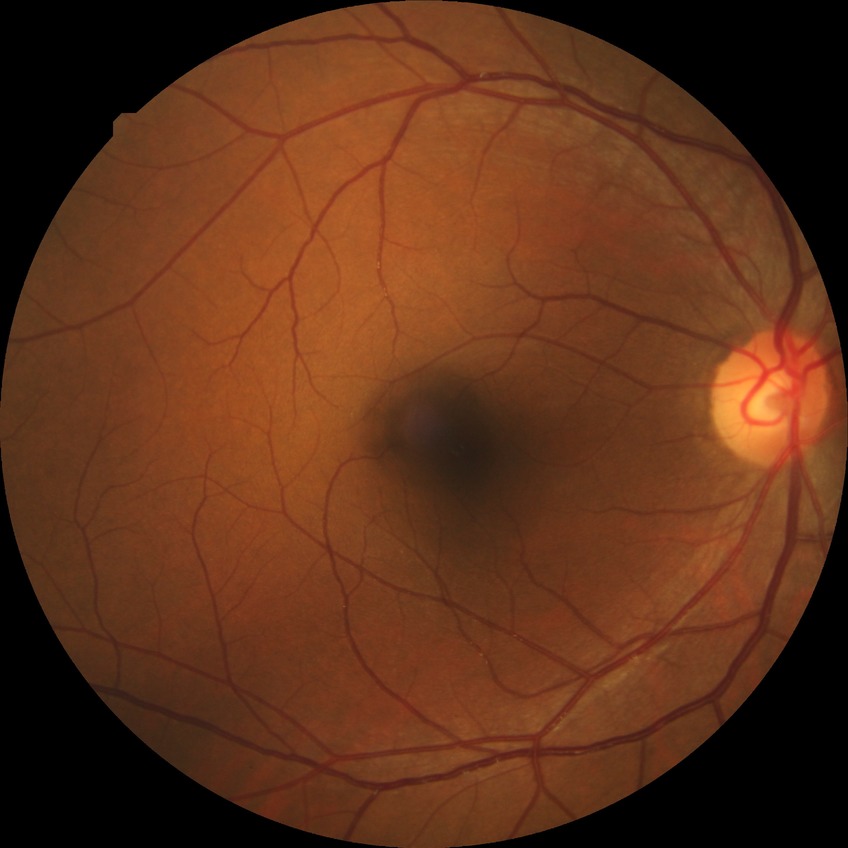

Retinopathy stage is no diabetic retinopathy.